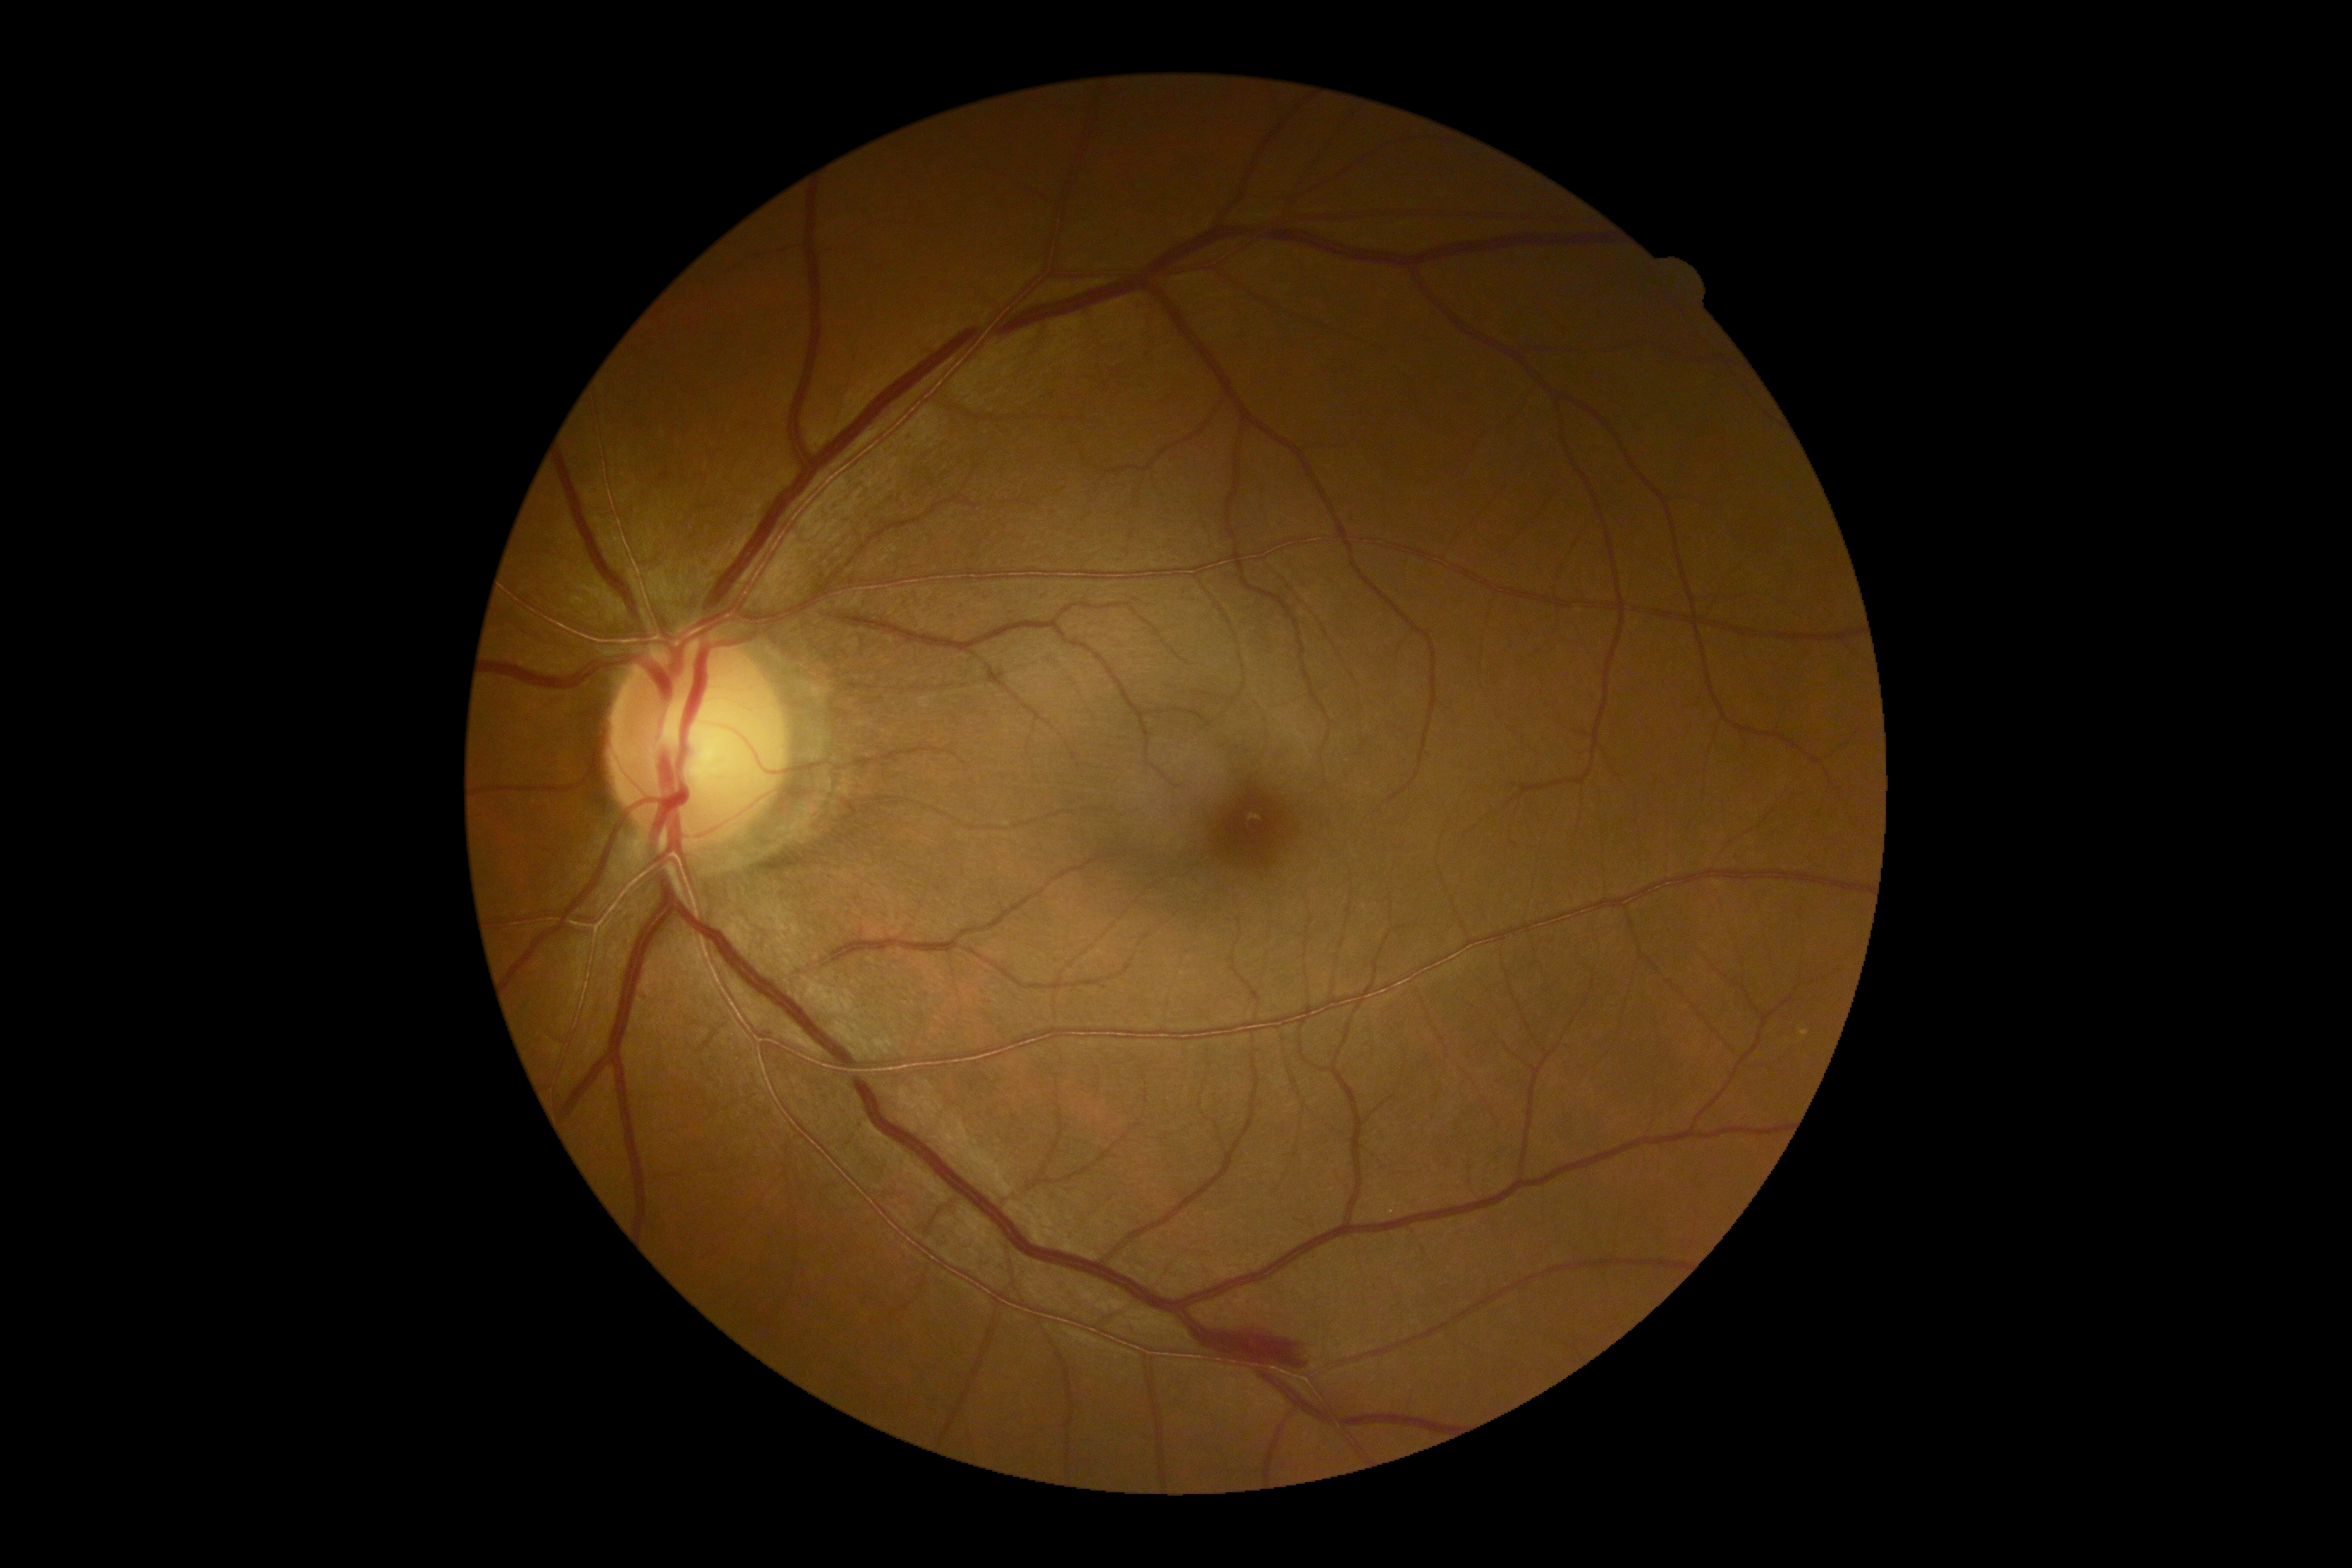
DR severity: grade 2.